Topcon TRC-50DX
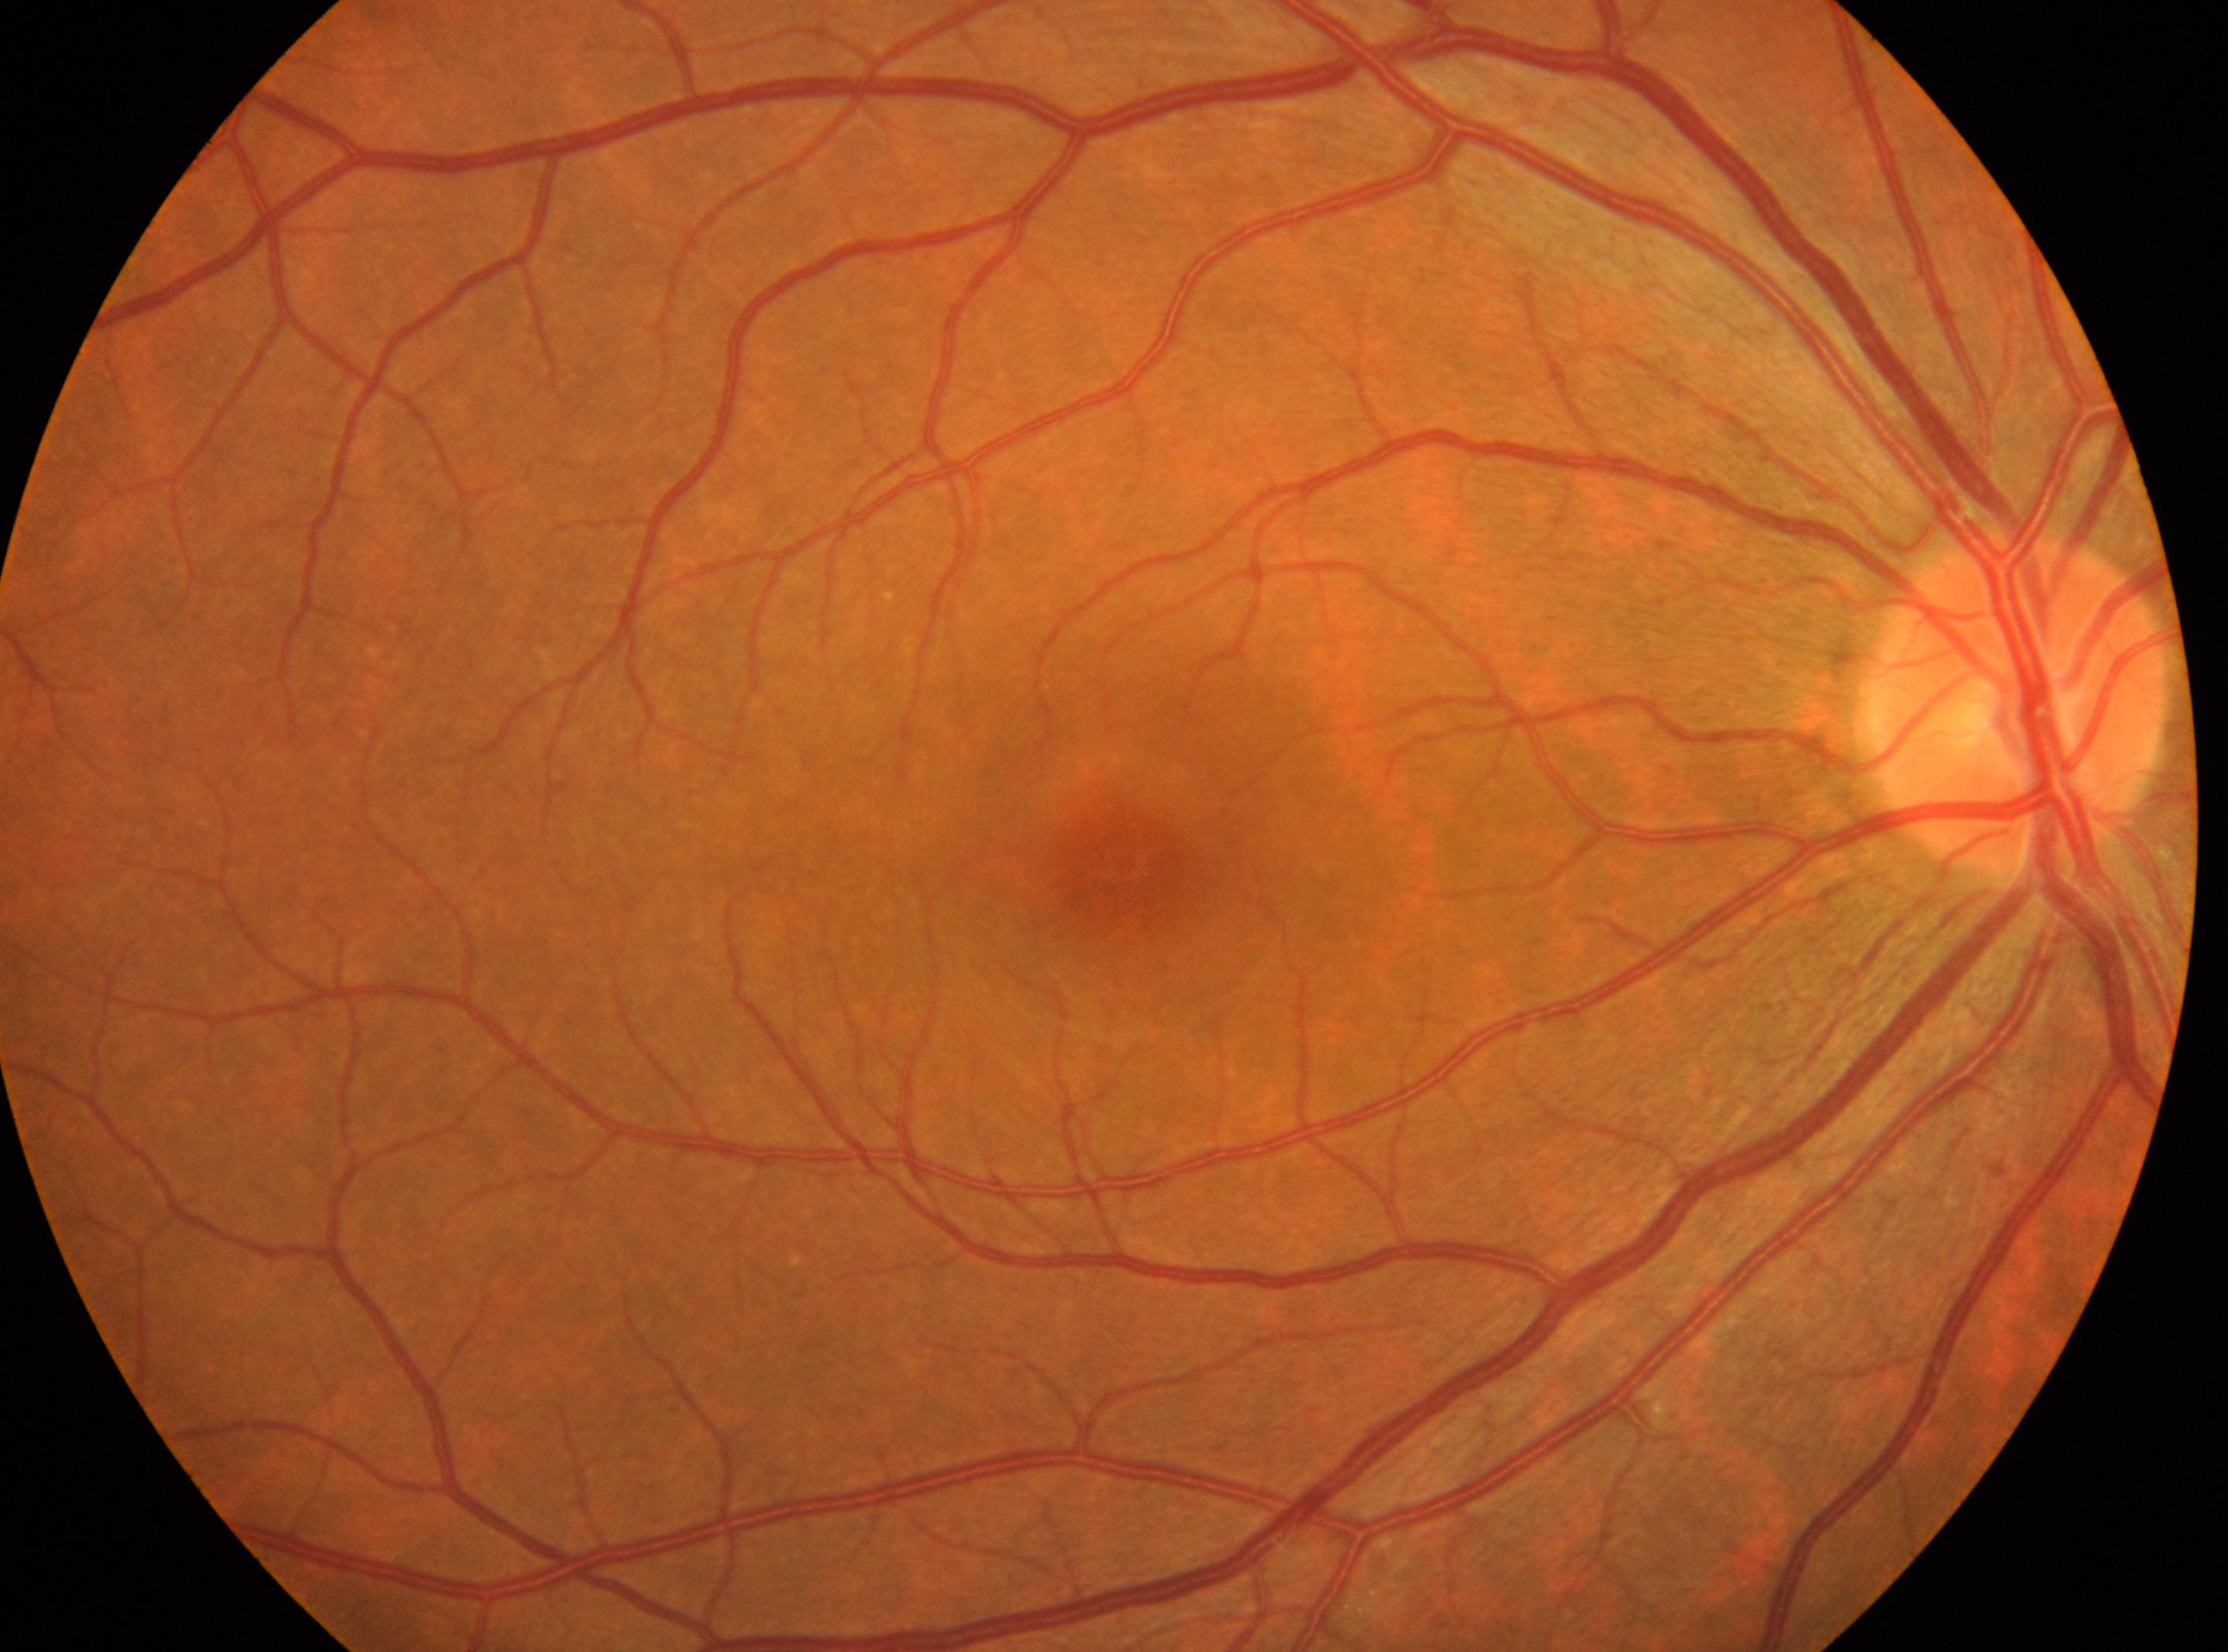

{"dr_impression": "No diabetic retinal disease findings", "fovea": "[1123, 868]", "eye": "the right eye", "optic_disc": "[2018, 702]", "dr_grade": "0"}